Color fundus photograph, no pharmacologic dilation, 848x848, camera: NIDEK AFC-230, 45° field of view: 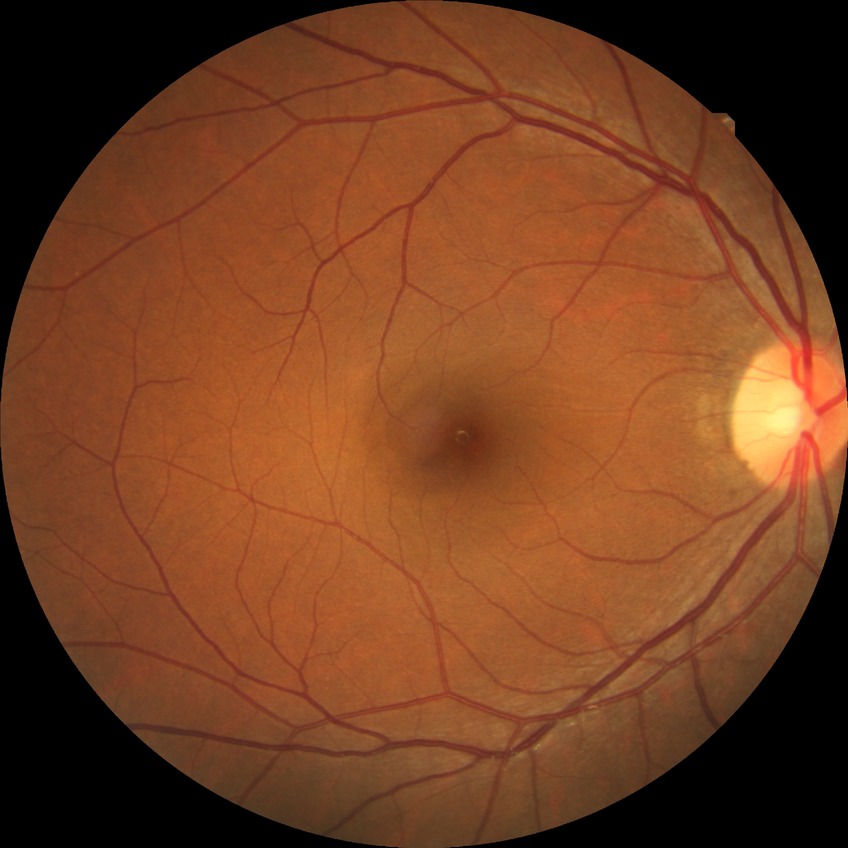

Diabetic retinopathy (DR): NDR (no diabetic retinopathy).